Without pupil dilation: 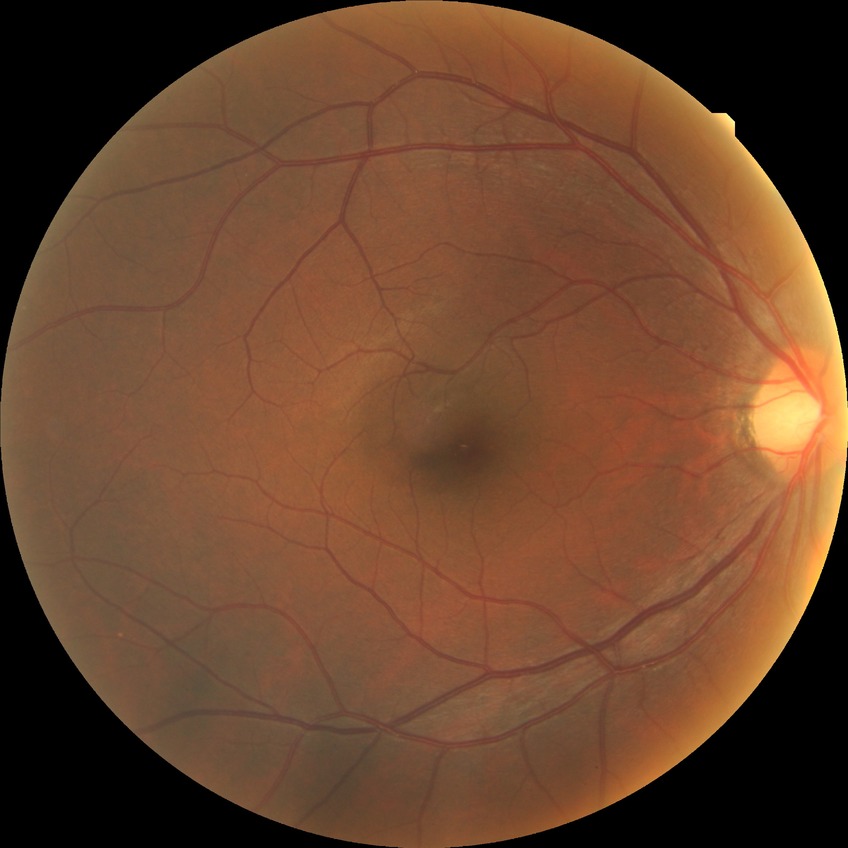

Davis grading: no diabetic retinopathy.